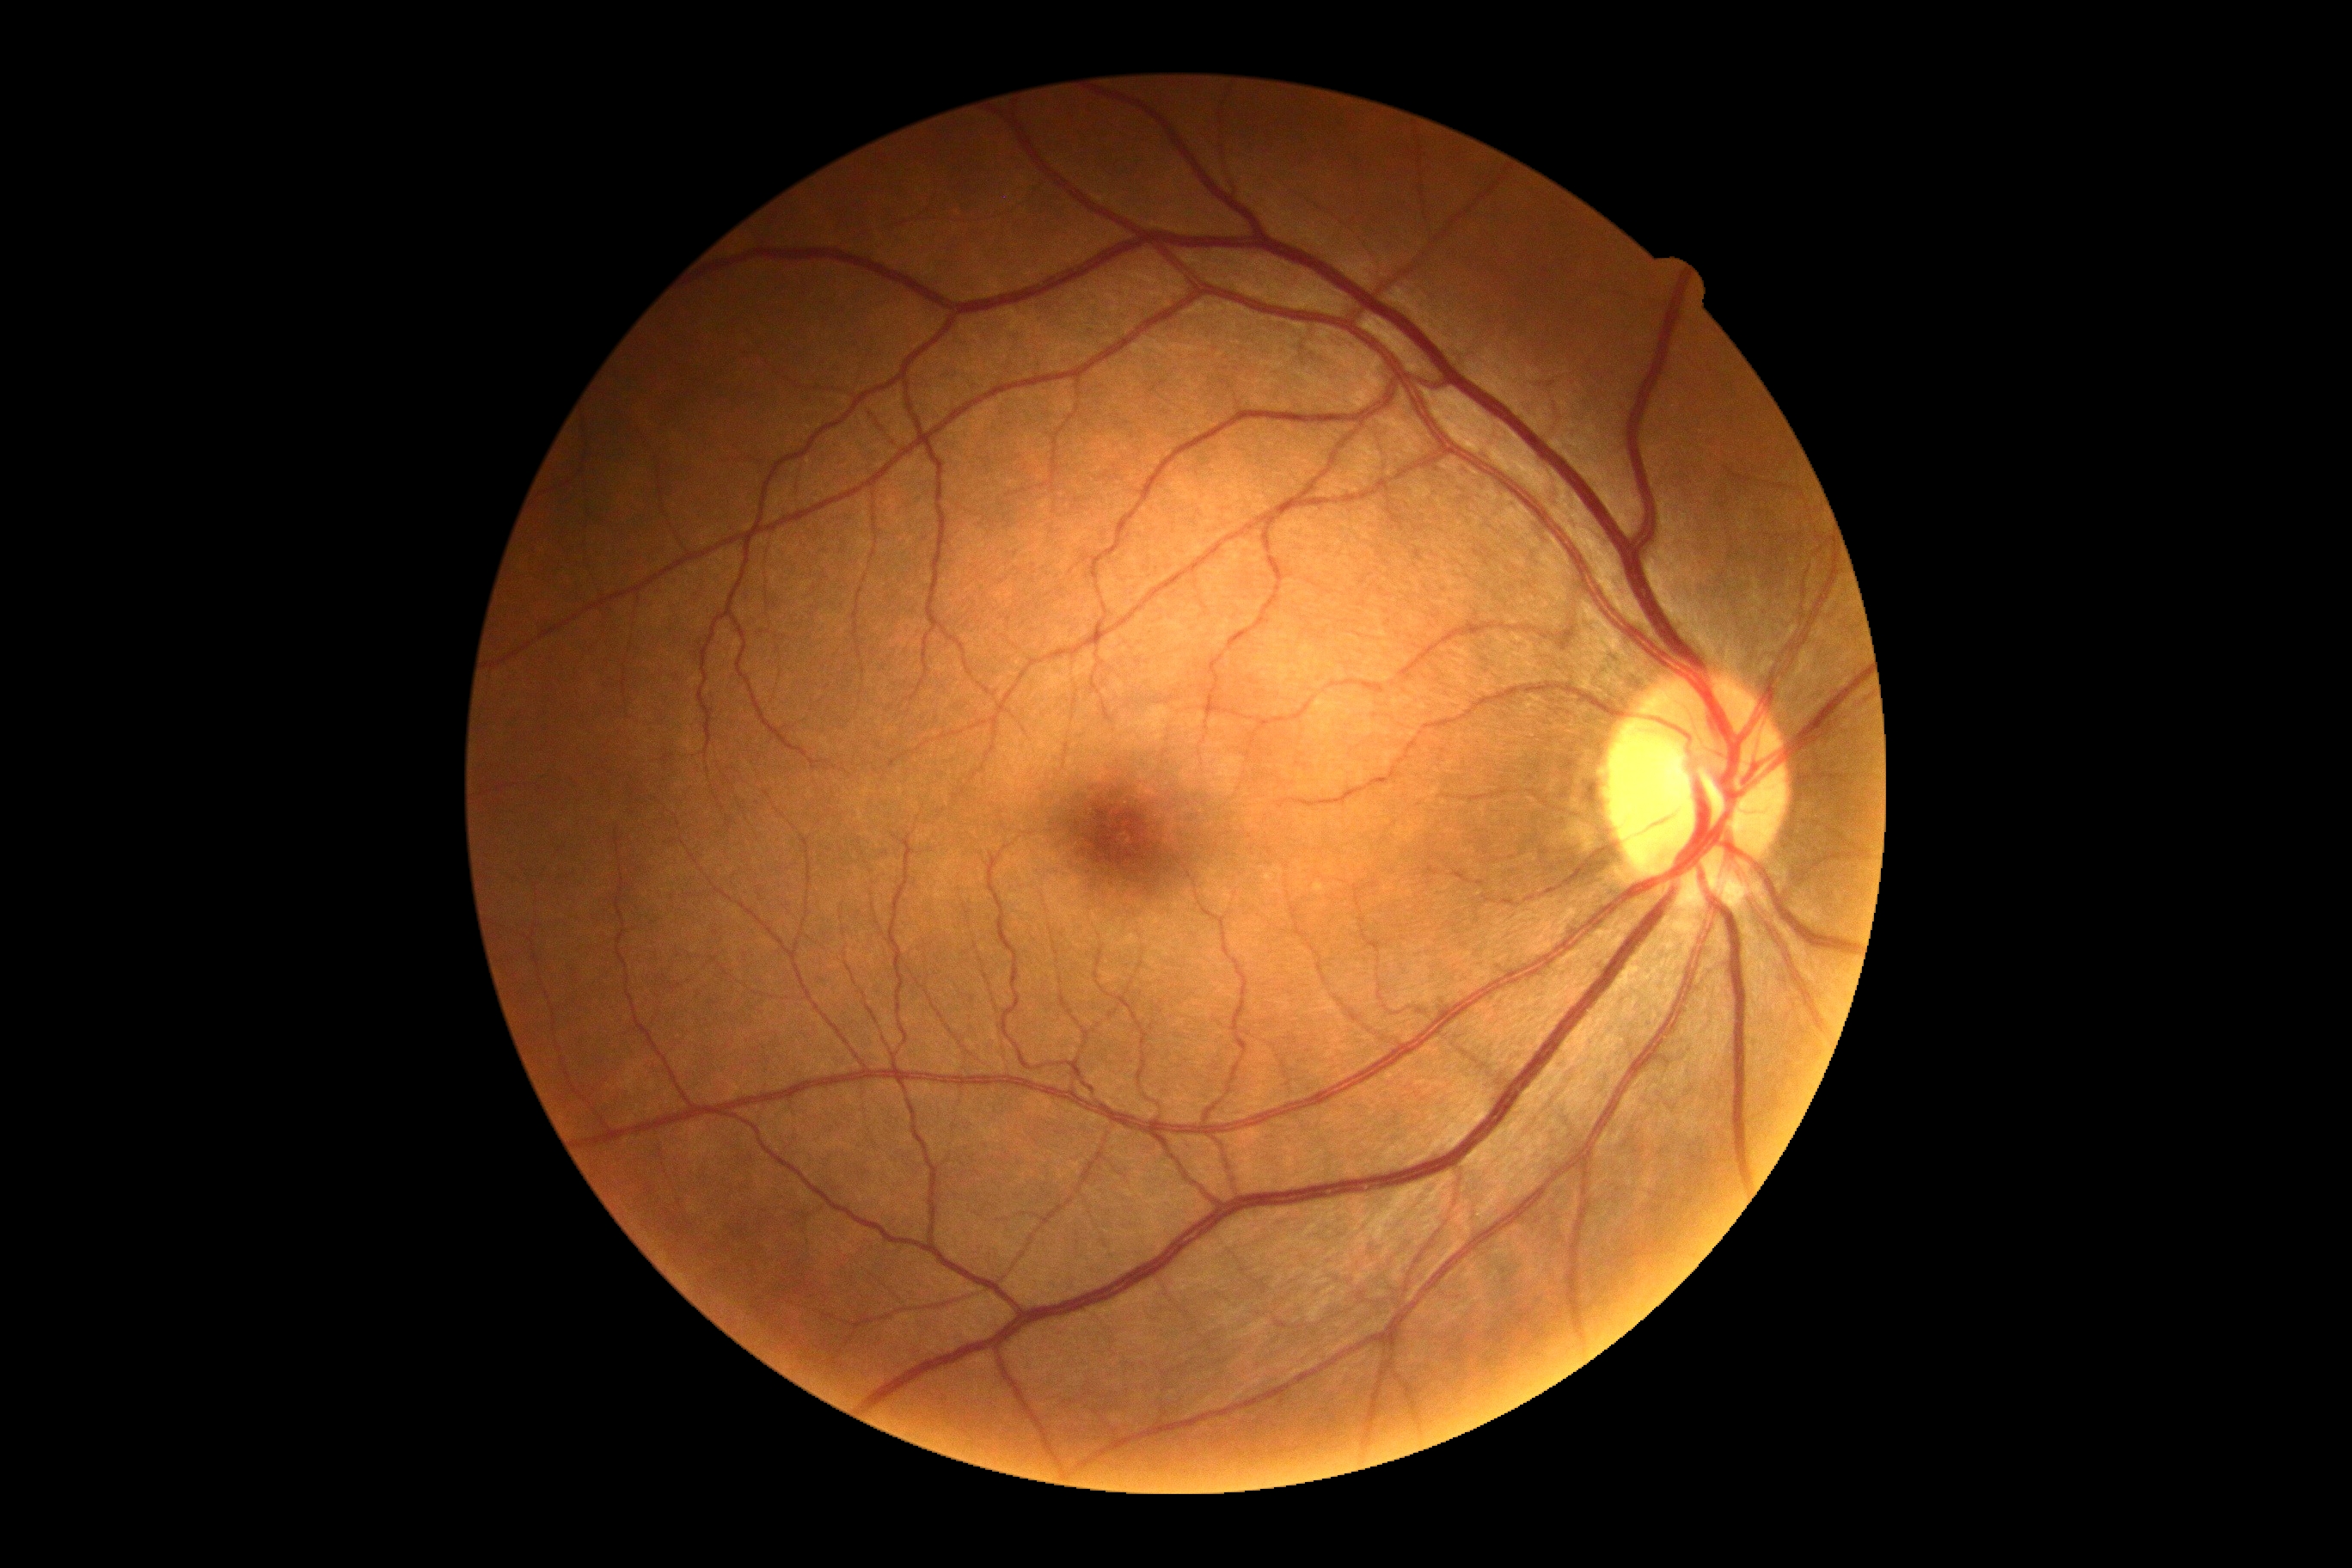
{"dr_grade": "no apparent retinopathy (grade 0)", "dr_impression": "no signs of DR"}